Image size 2212x1659; retinal fundus photograph: 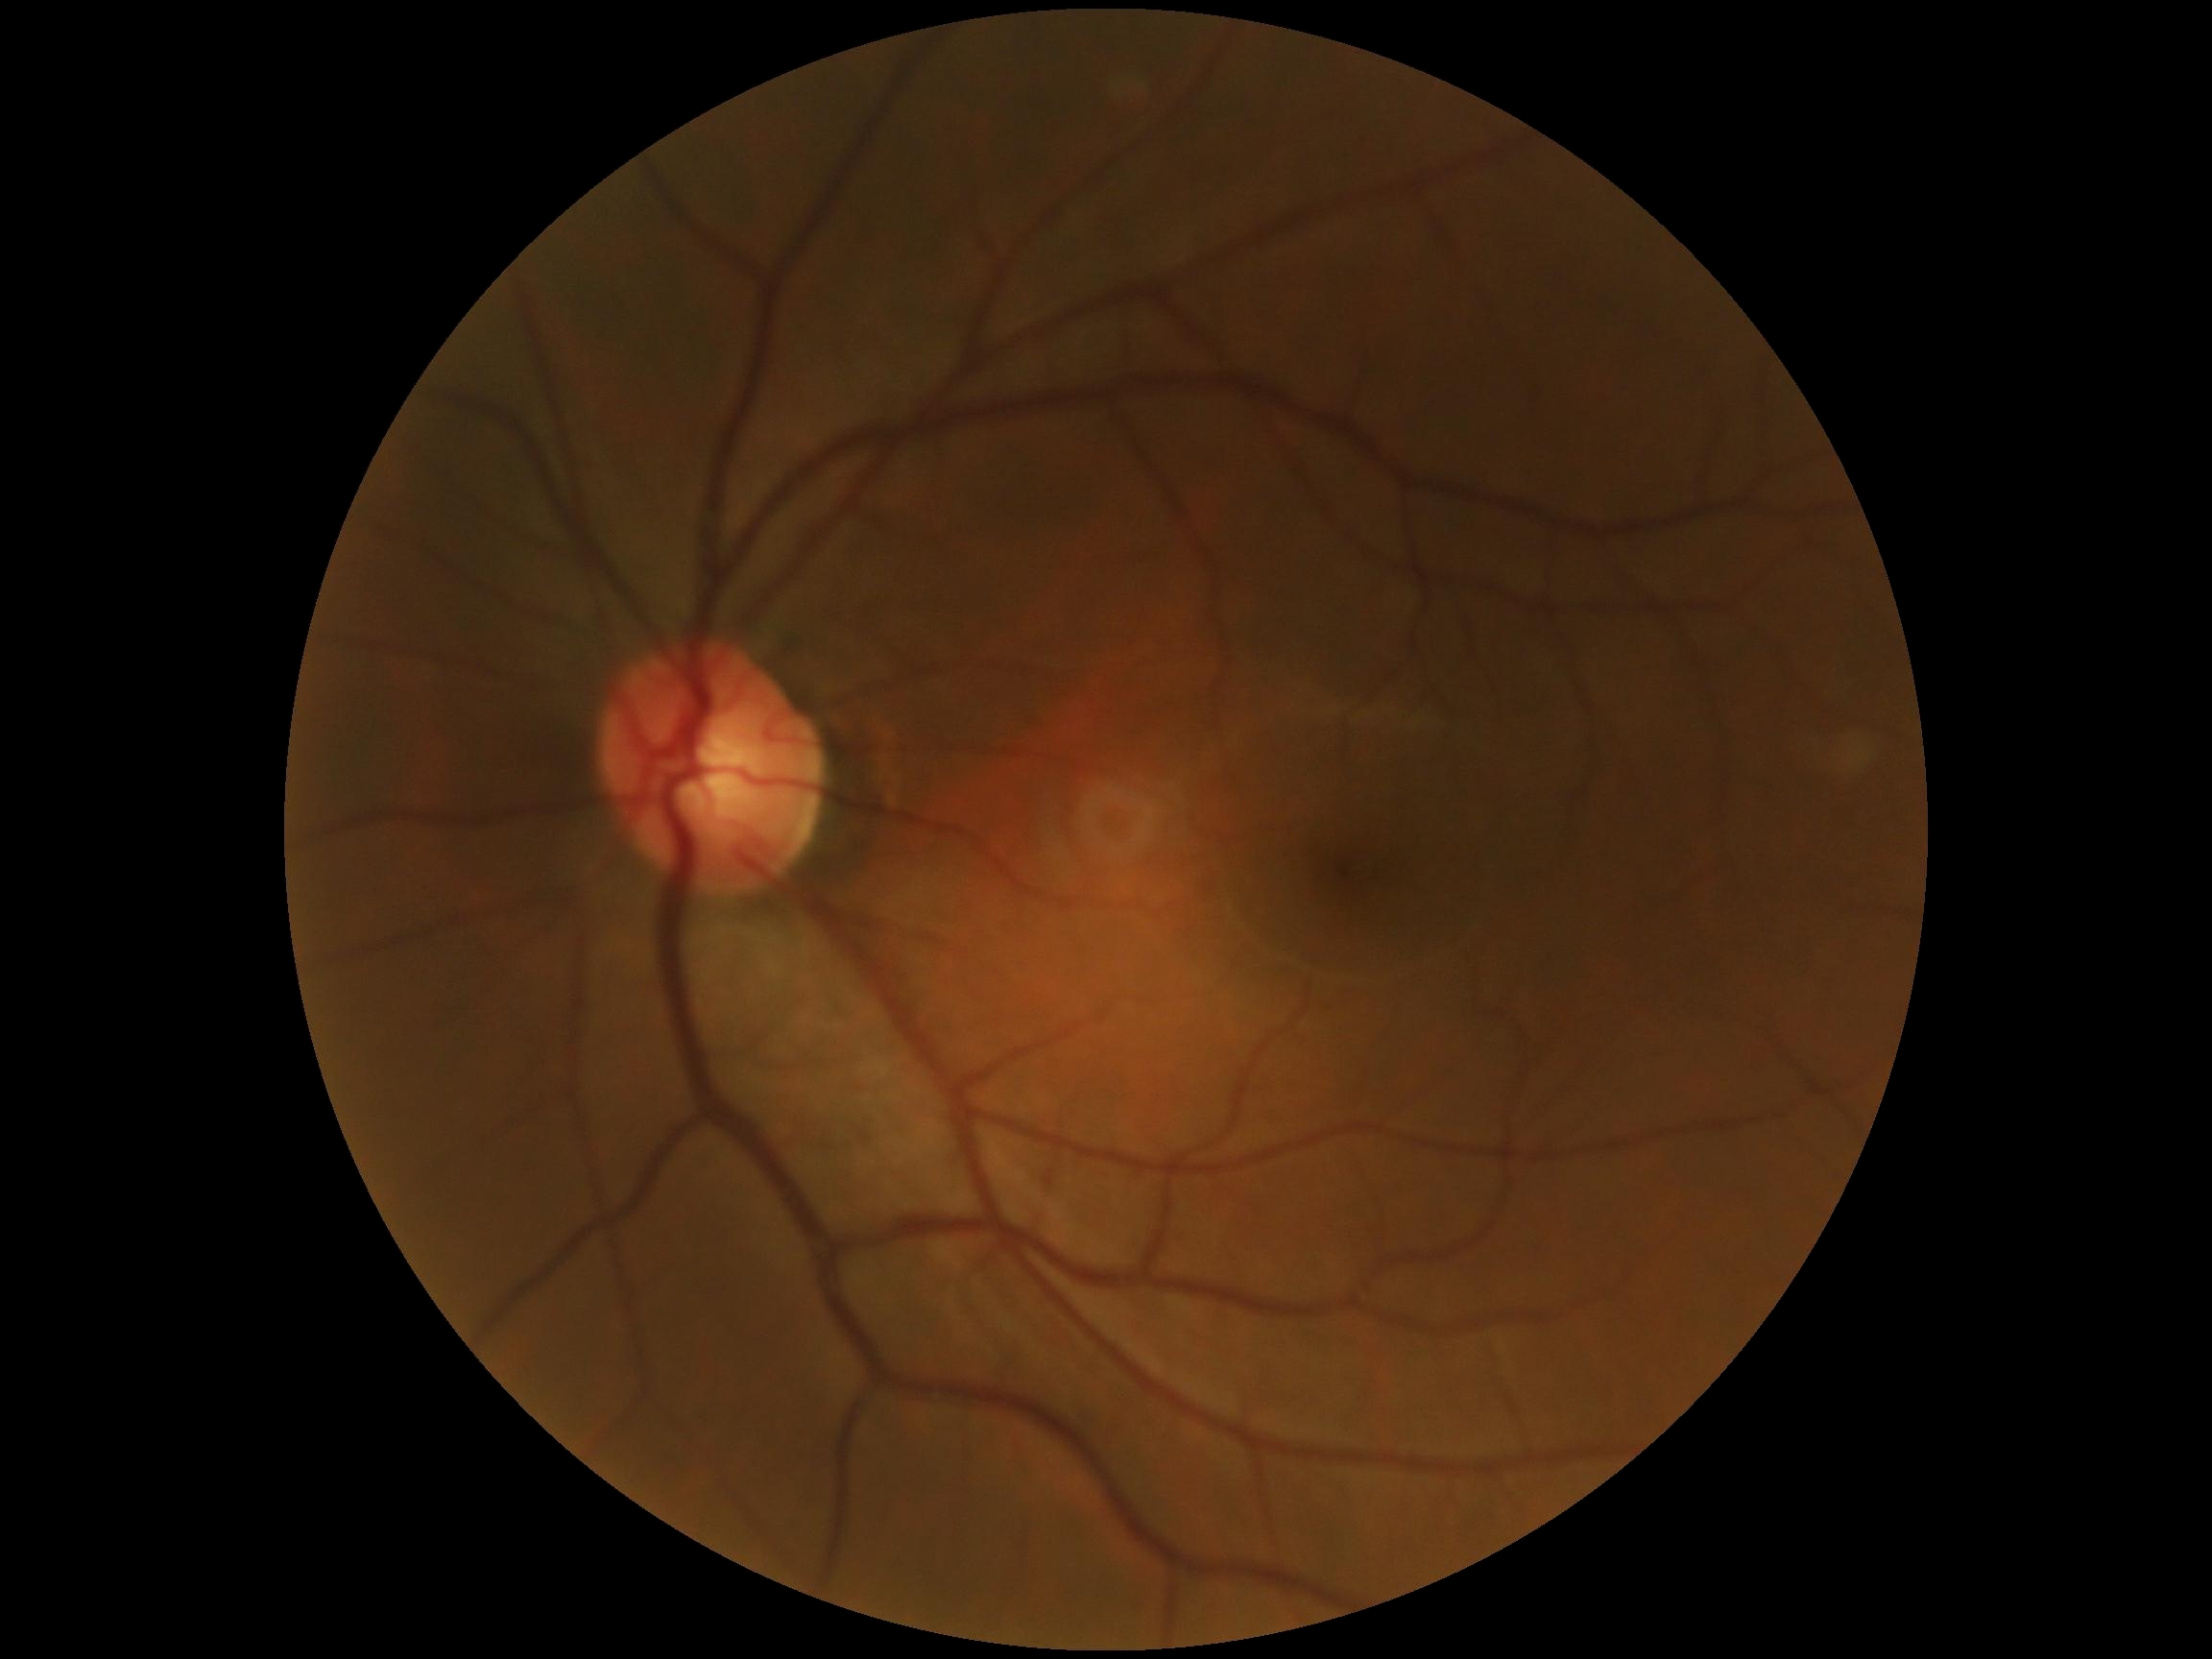

Retinopathy grade is 0 (no apparent retinopathy).